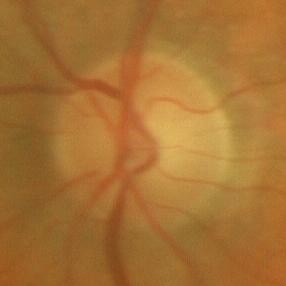 Showing no glaucomatous changes.